2048 by 1536 pixels — 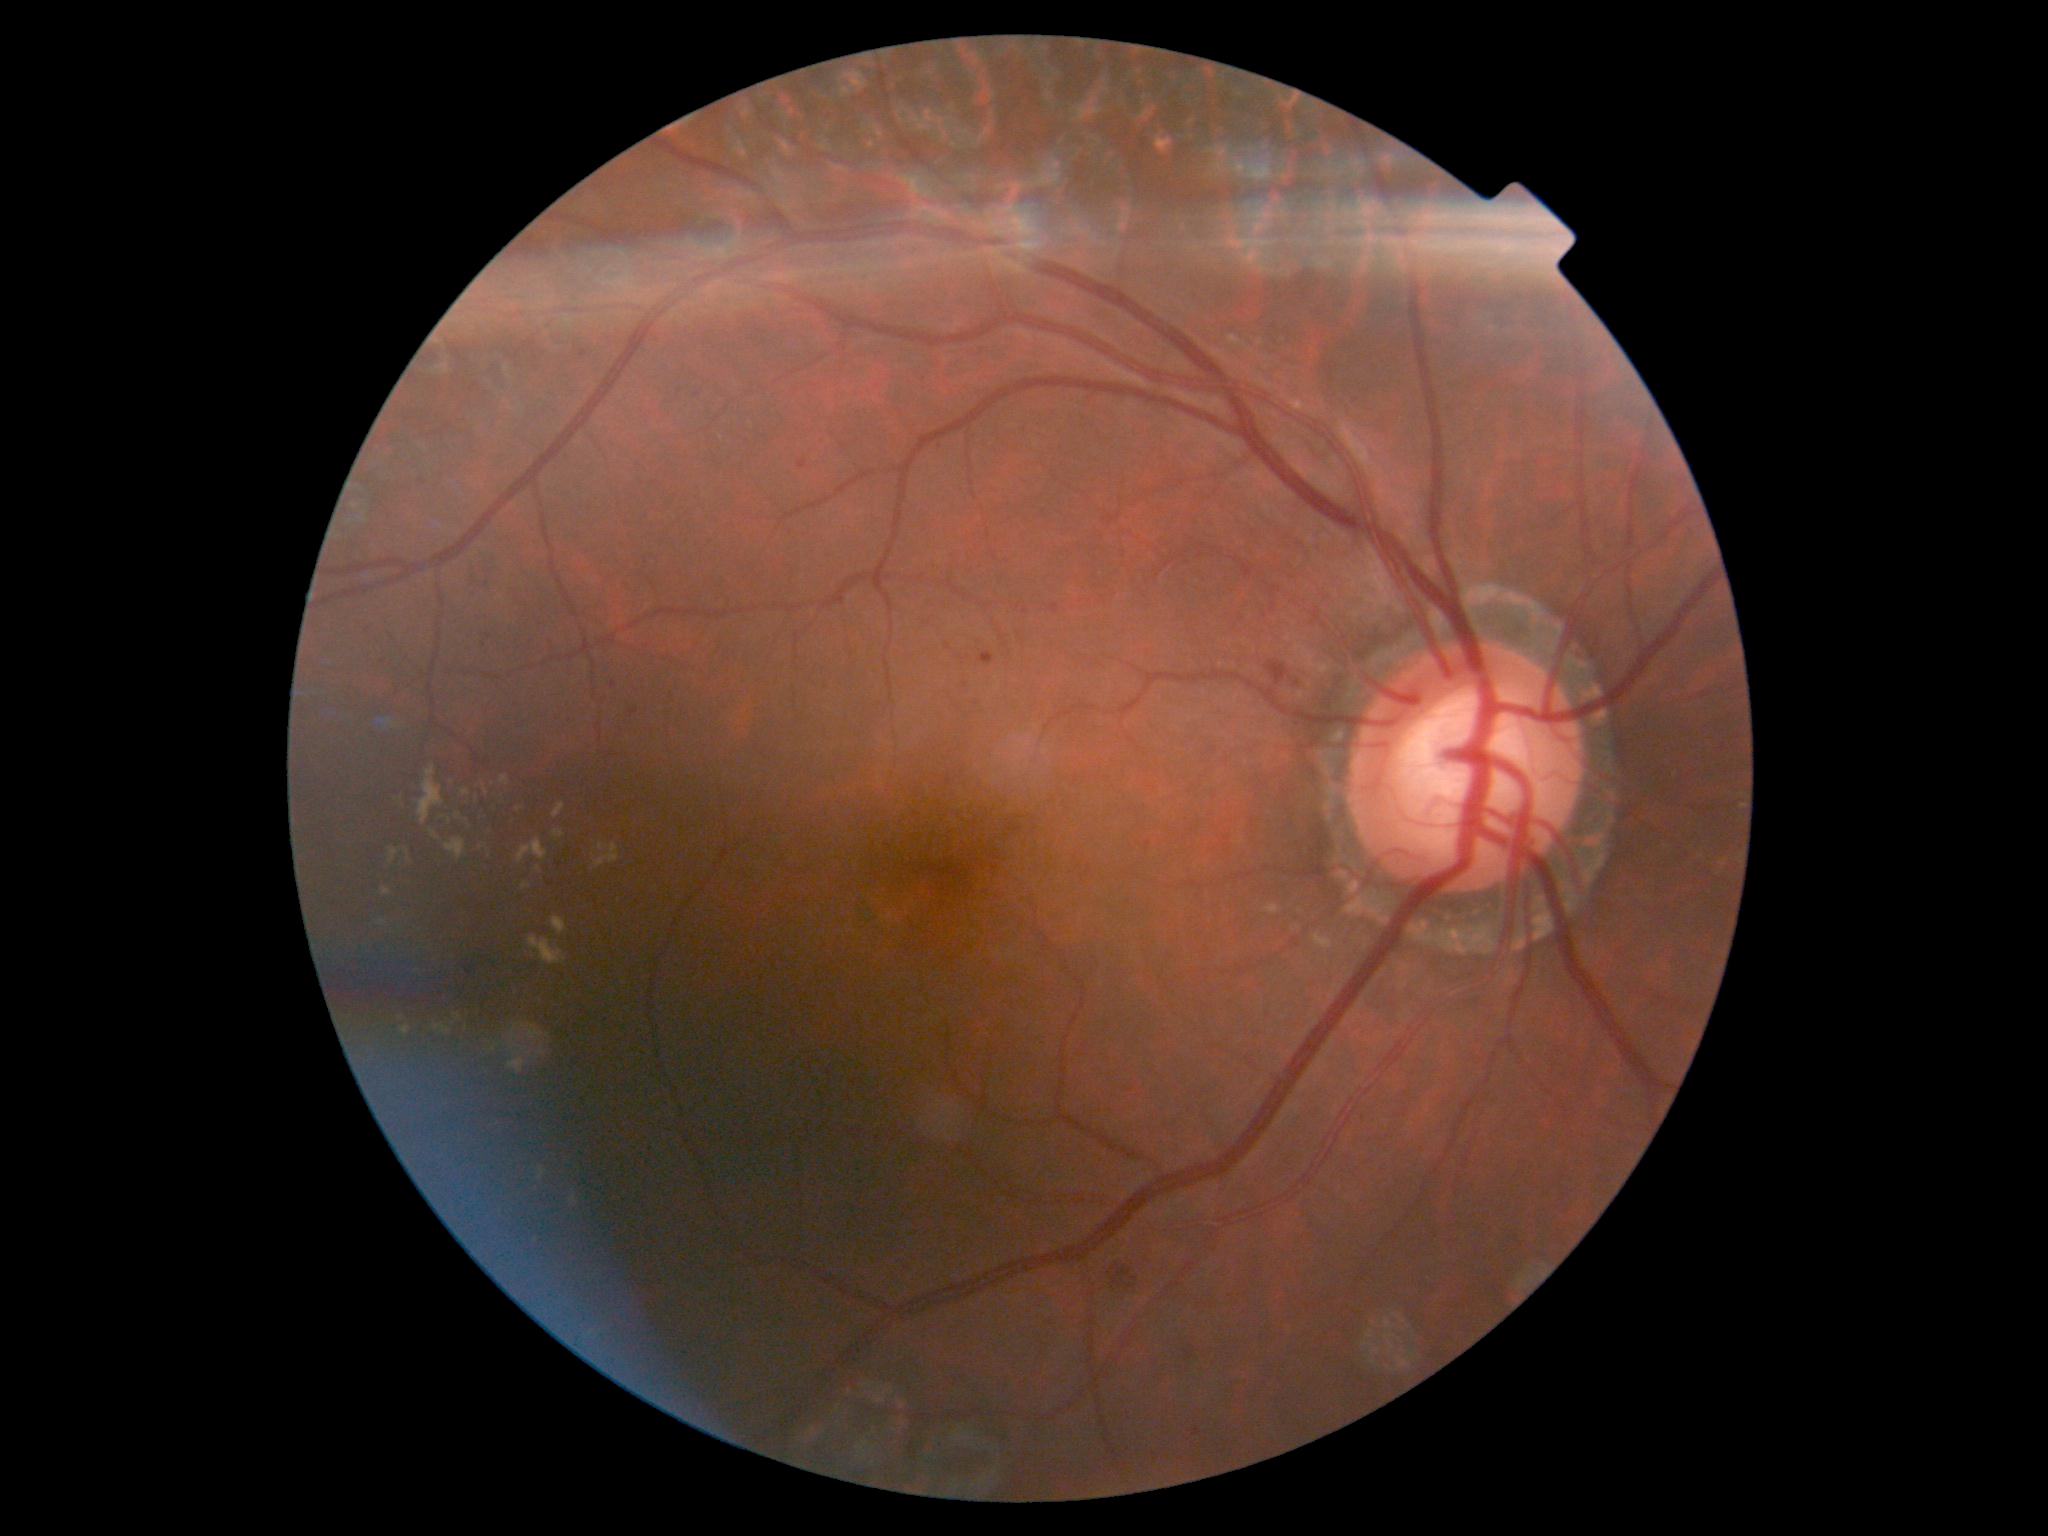

<lesions partial="true">
  <dr_grade>2</dr_grade>
  <ex partial="true">bbox=[483, 785, 489, 795] | bbox=[419, 767, 445, 826] | bbox=[518, 838, 548, 864] | bbox=[501, 777, 509, 787] | bbox=[598, 844, 608, 851] | bbox=[527, 1045, 547, 1061] | bbox=[446, 838, 465, 860] | bbox=[528, 937, 567, 965] | bbox=[552, 804, 565, 820] | bbox=[552, 830, 565, 838] | bbox=[570, 1197, 578, 1204] | bbox=[492, 1043, 502, 1052] | bbox=[377, 920, 387, 927] | bbox=[436, 1025, 451, 1035]</ex>
  <ex_small>(x=519, y=809) | (x=549, y=1036) | (x=450, y=822)</ex_small>
  <se />
  <ma>bbox=[978, 652, 994, 666] | bbox=[611, 682, 617, 691] | bbox=[799, 461, 808, 470] | bbox=[630, 709, 638, 716]</ma>
  <ma_small>(x=949, y=781) | (x=469, y=972)</ma_small>
  <he partial="true">bbox=[1184, 1351, 1195, 1361] | bbox=[934, 1444, 986, 1480] | bbox=[1265, 662, 1290, 686] | bbox=[1112, 1264, 1132, 1287] | bbox=[1128, 1286, 1136, 1289]</he>
  <he_small>(x=1114, y=1270) | (x=1134, y=1279)</he_small>
</lesions>